Wide-field fundus photograph of an infant
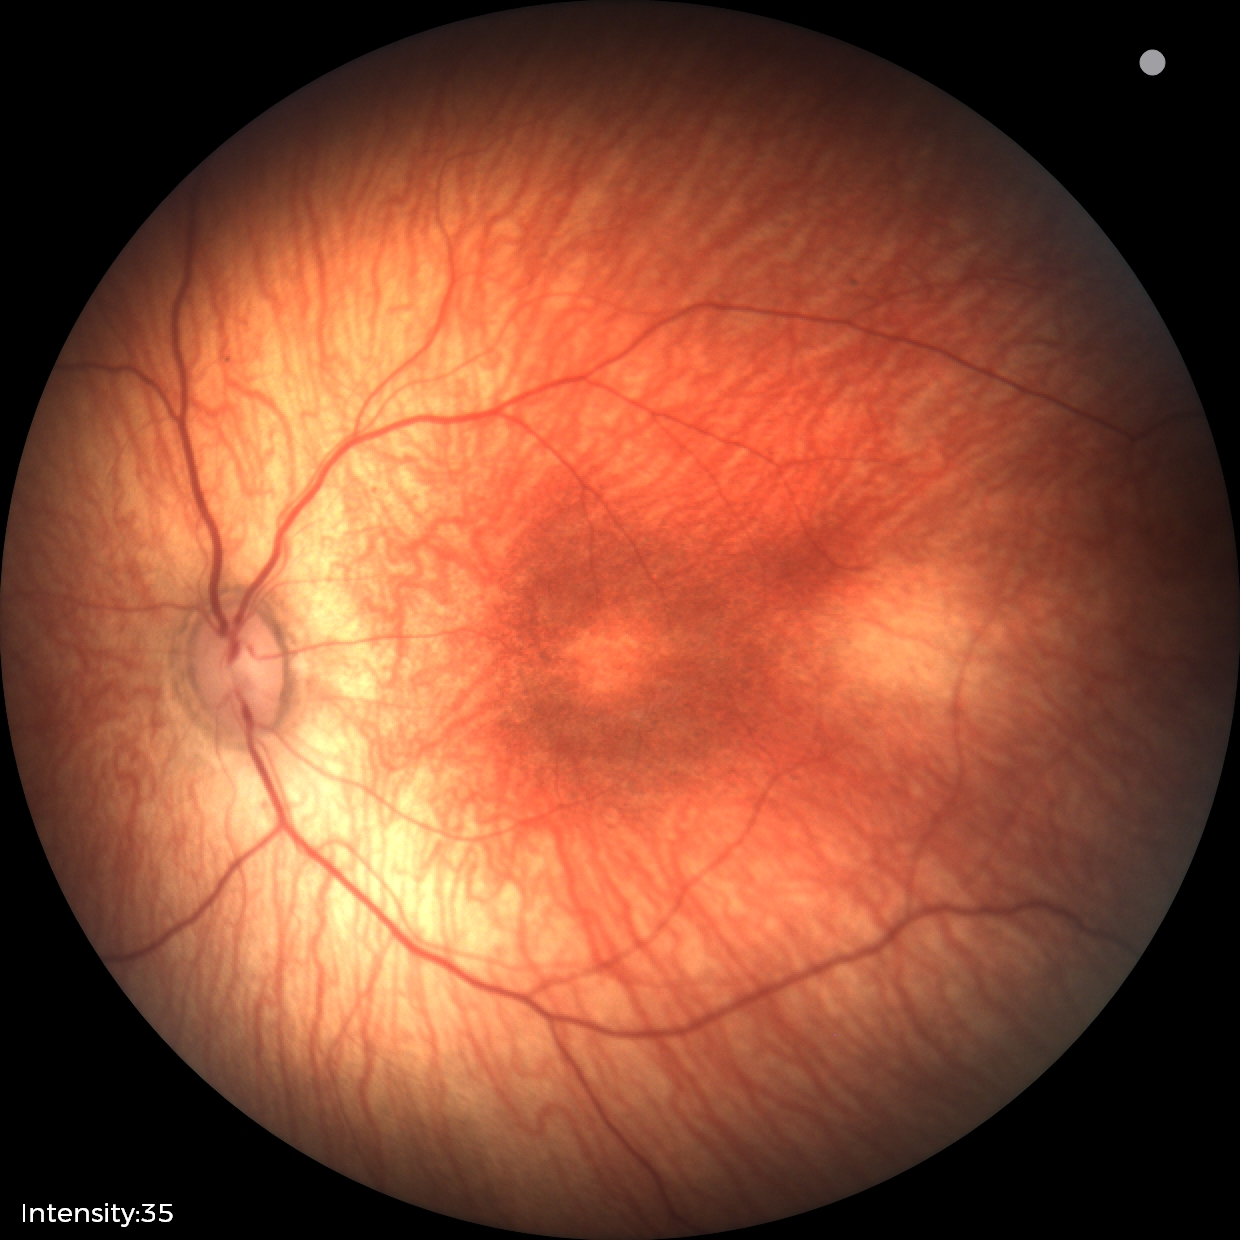

From an examination with diagnosis of status post retinopathy of prematurity. No plus disease.